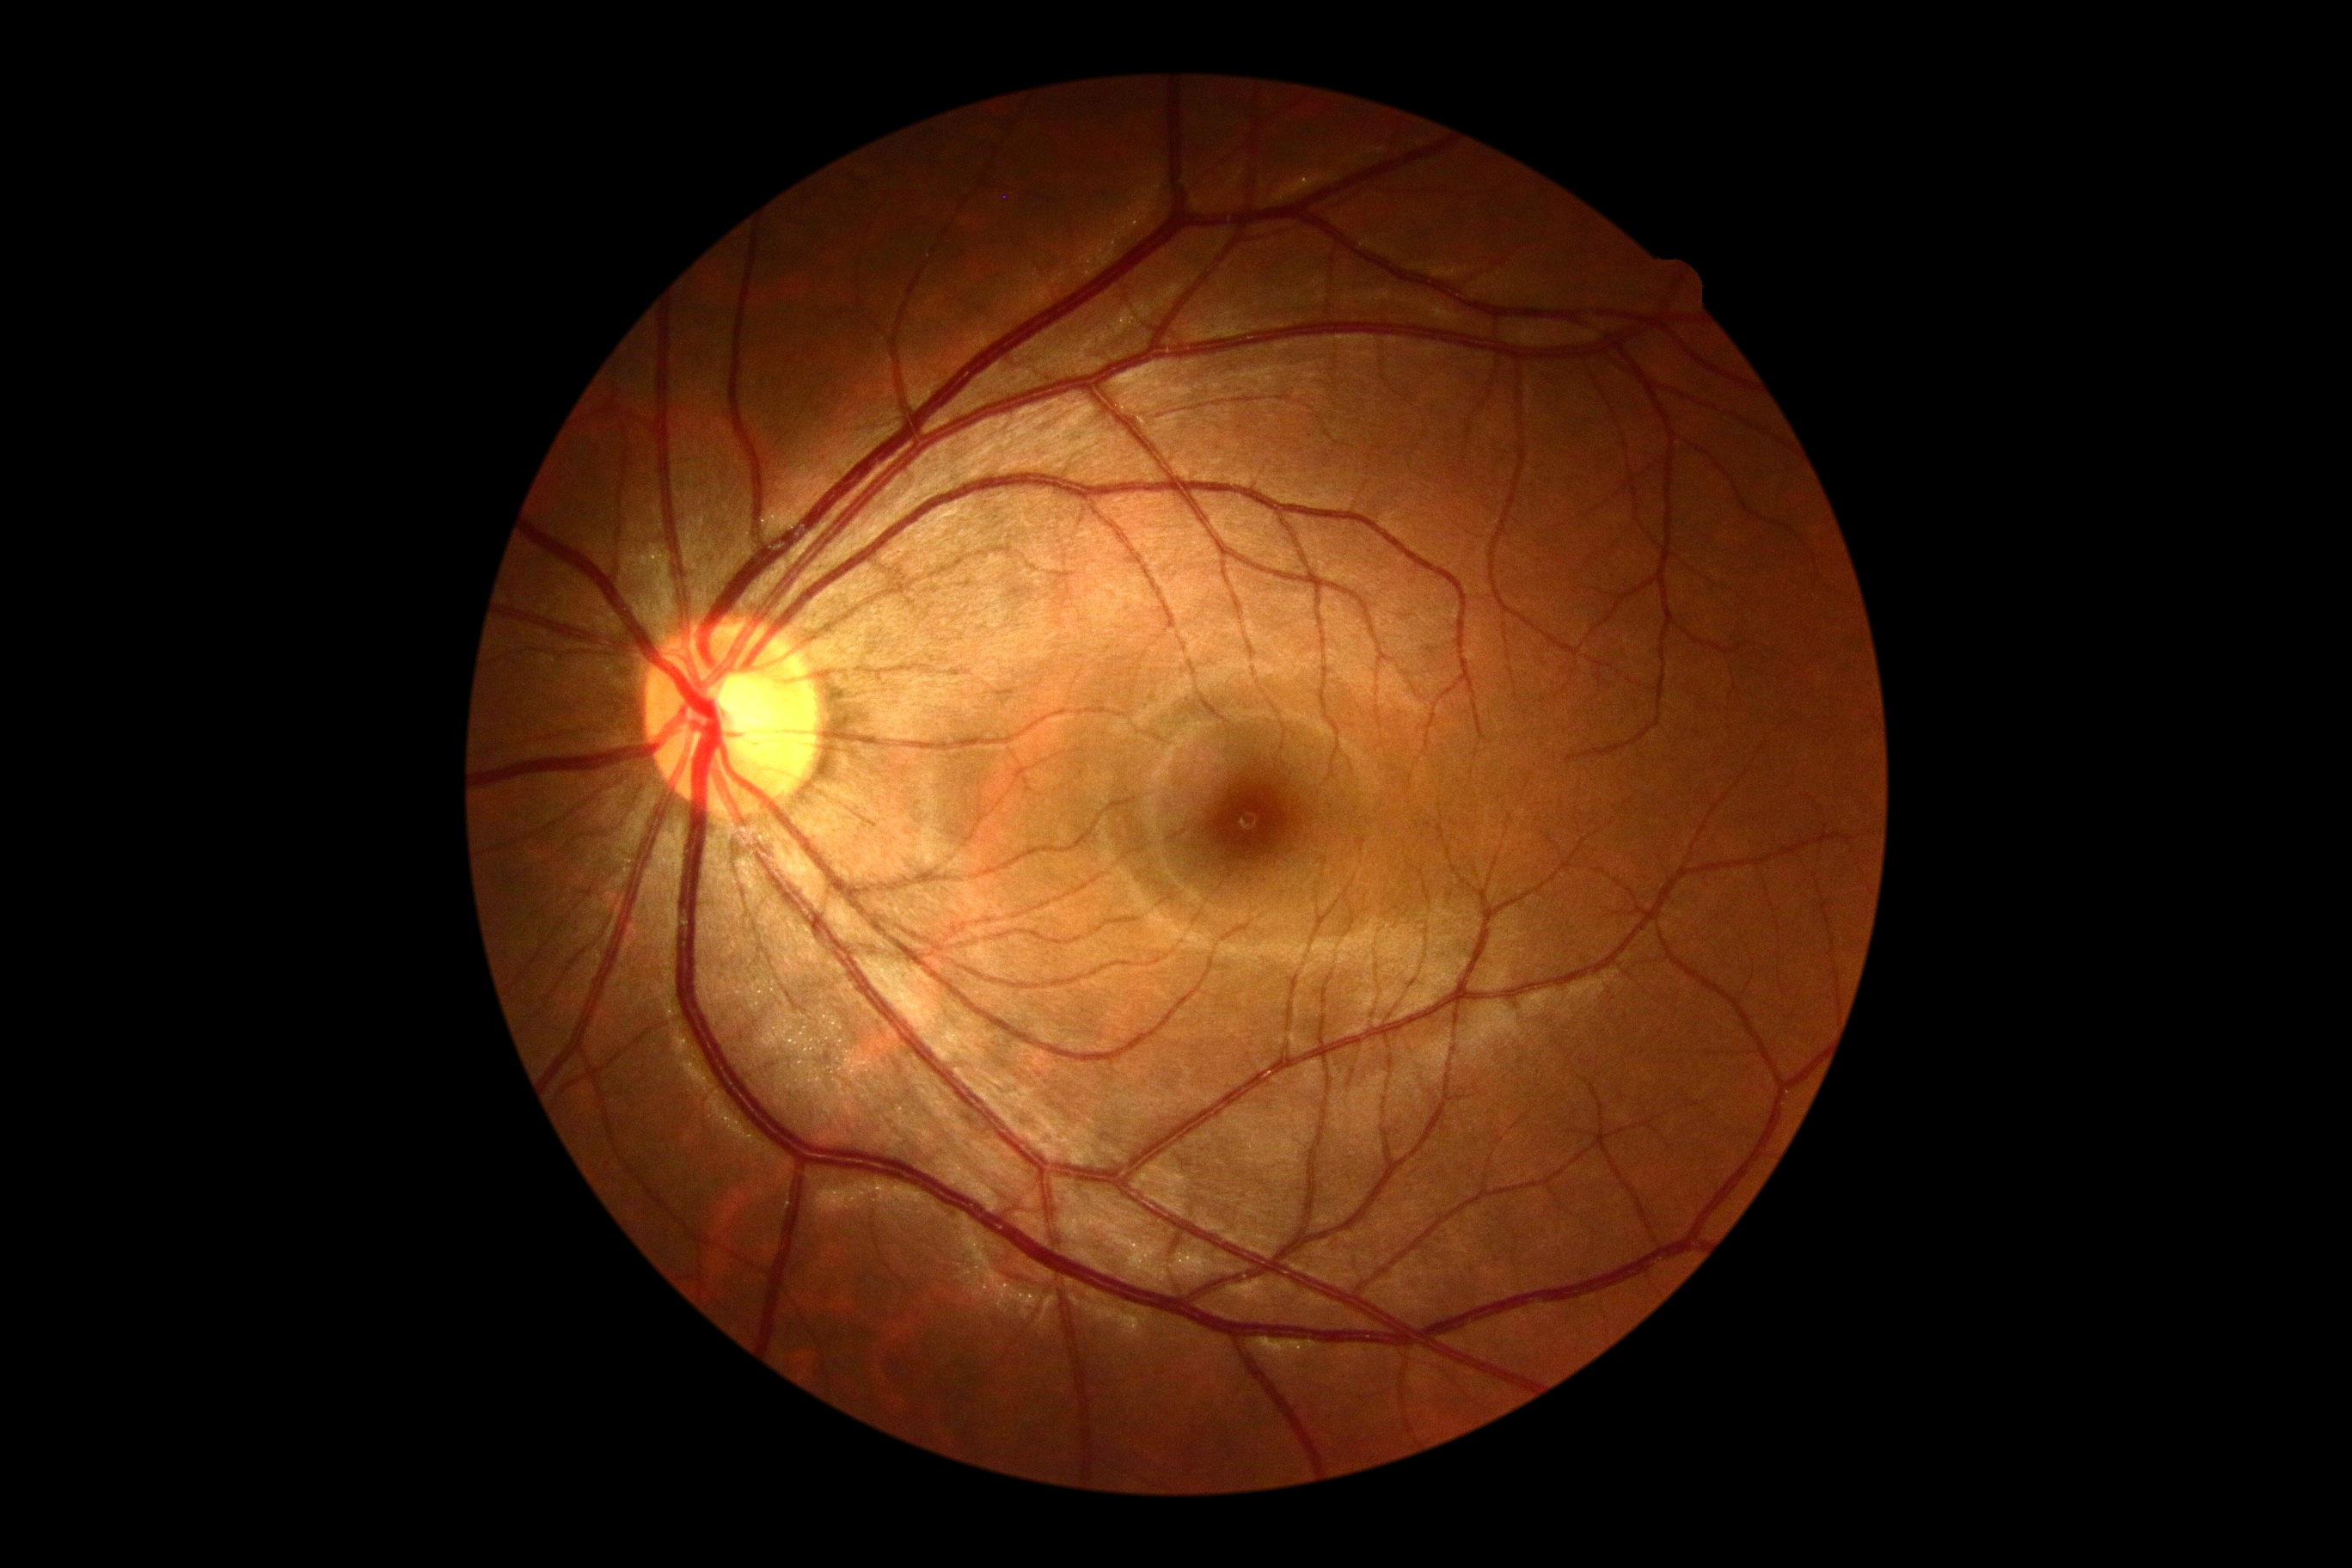 No signs of diabetic retinopathy.
DR is no apparent retinopathy (grade 0) — no visible signs of diabetic retinopathy.